NIDEK AFC-230 fundus camera: 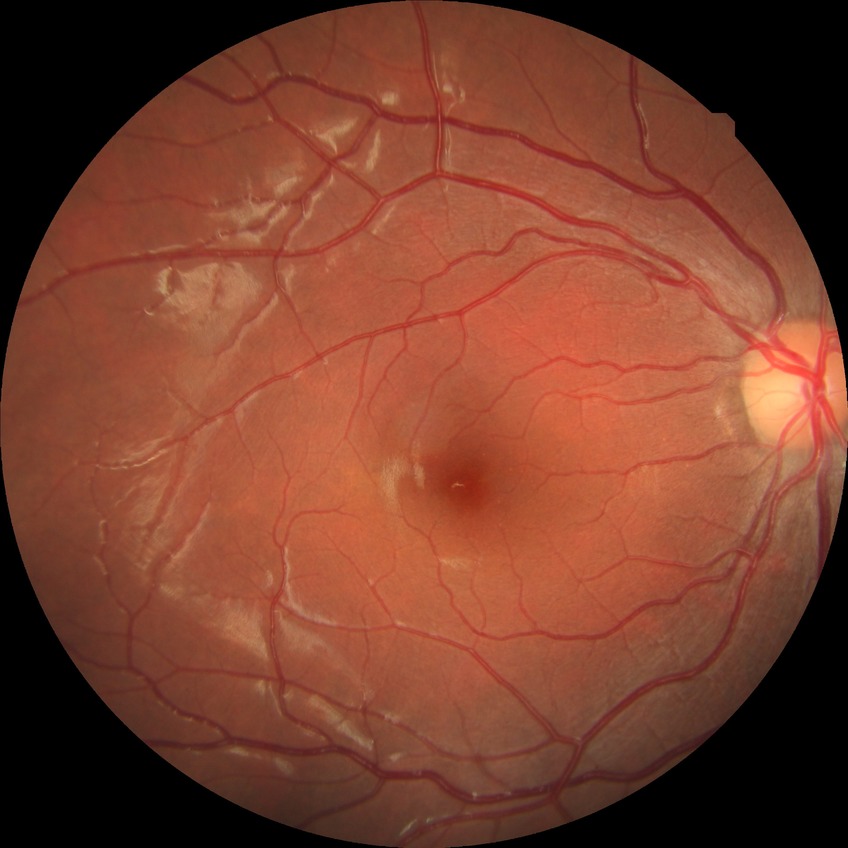

  davis_grade: no diabetic retinopathy